CFP: 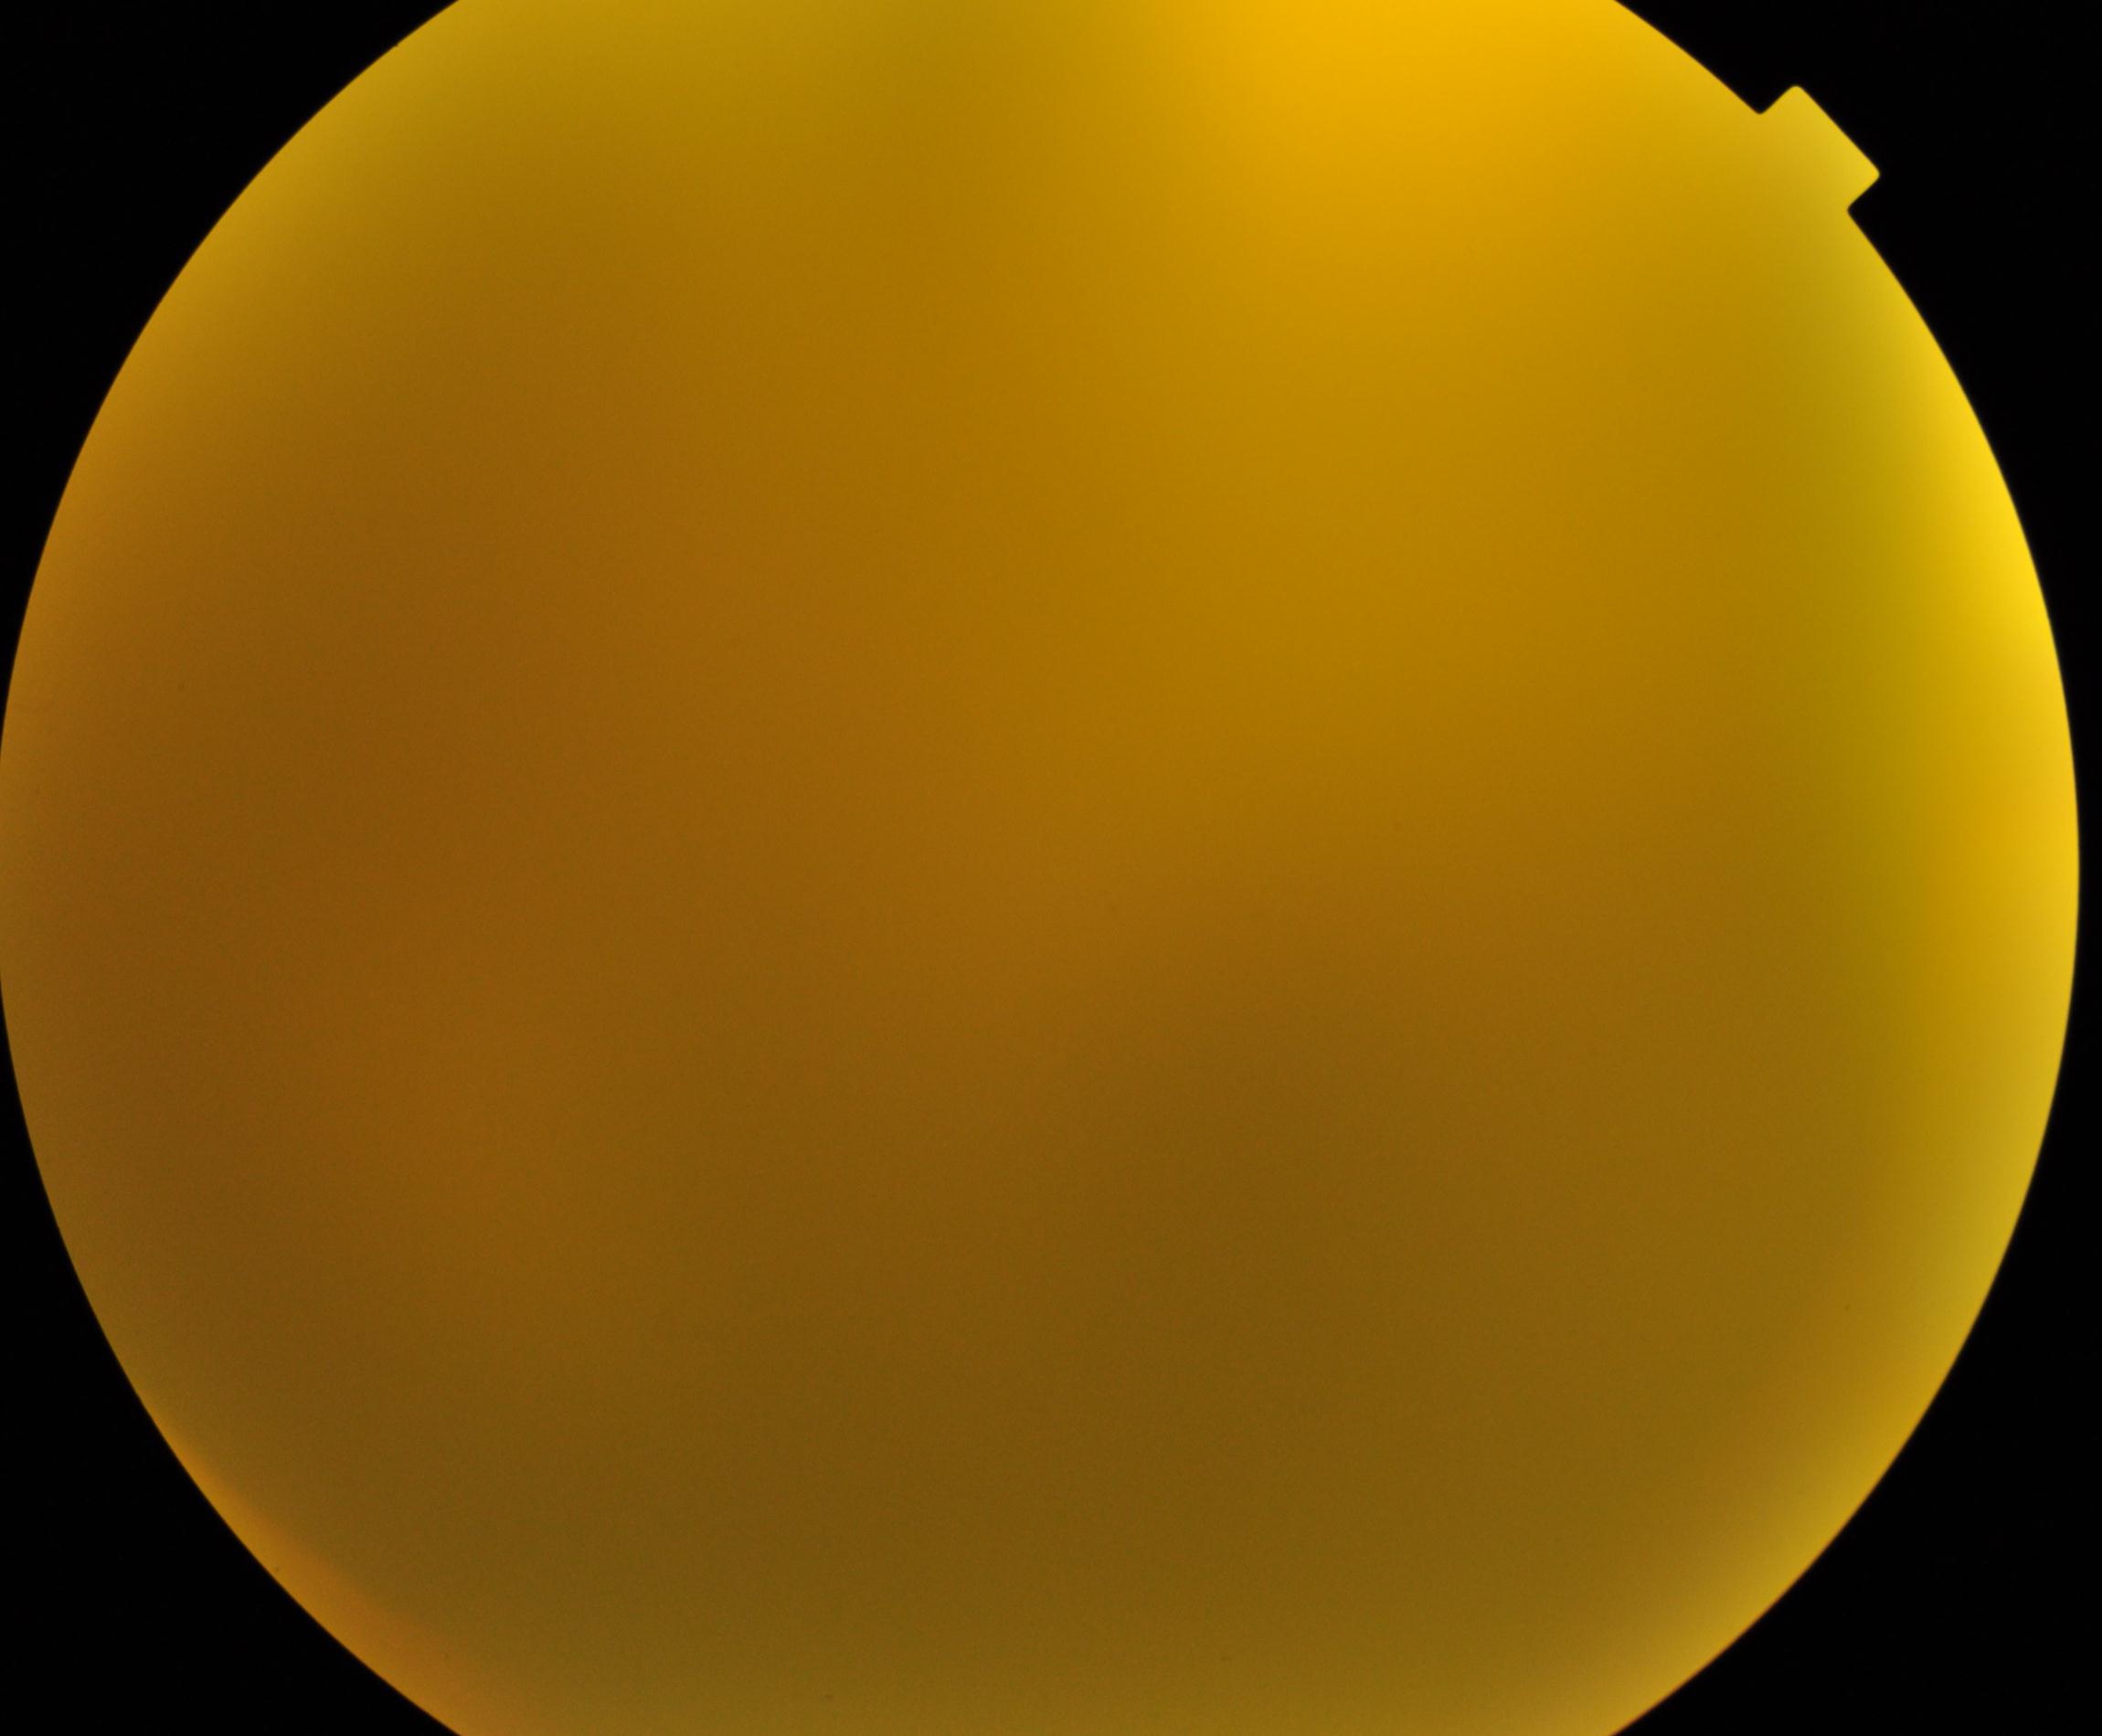

Significantly degraded image quality with obscured retinal detail. No evidence of proliferative diabetic retinopathy.